Infant wide-field retinal image · captured with the Clarity RetCam 3 (130° field of view).
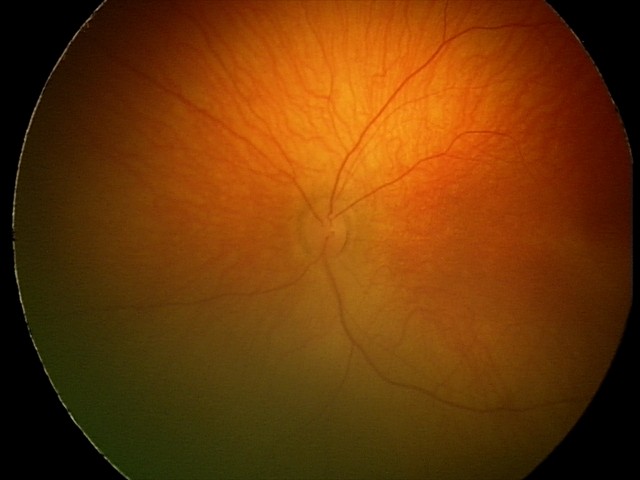
Diagnosis from this screening exam: retinal hemorrhages.